Portable fundus camera image. 60° FOV
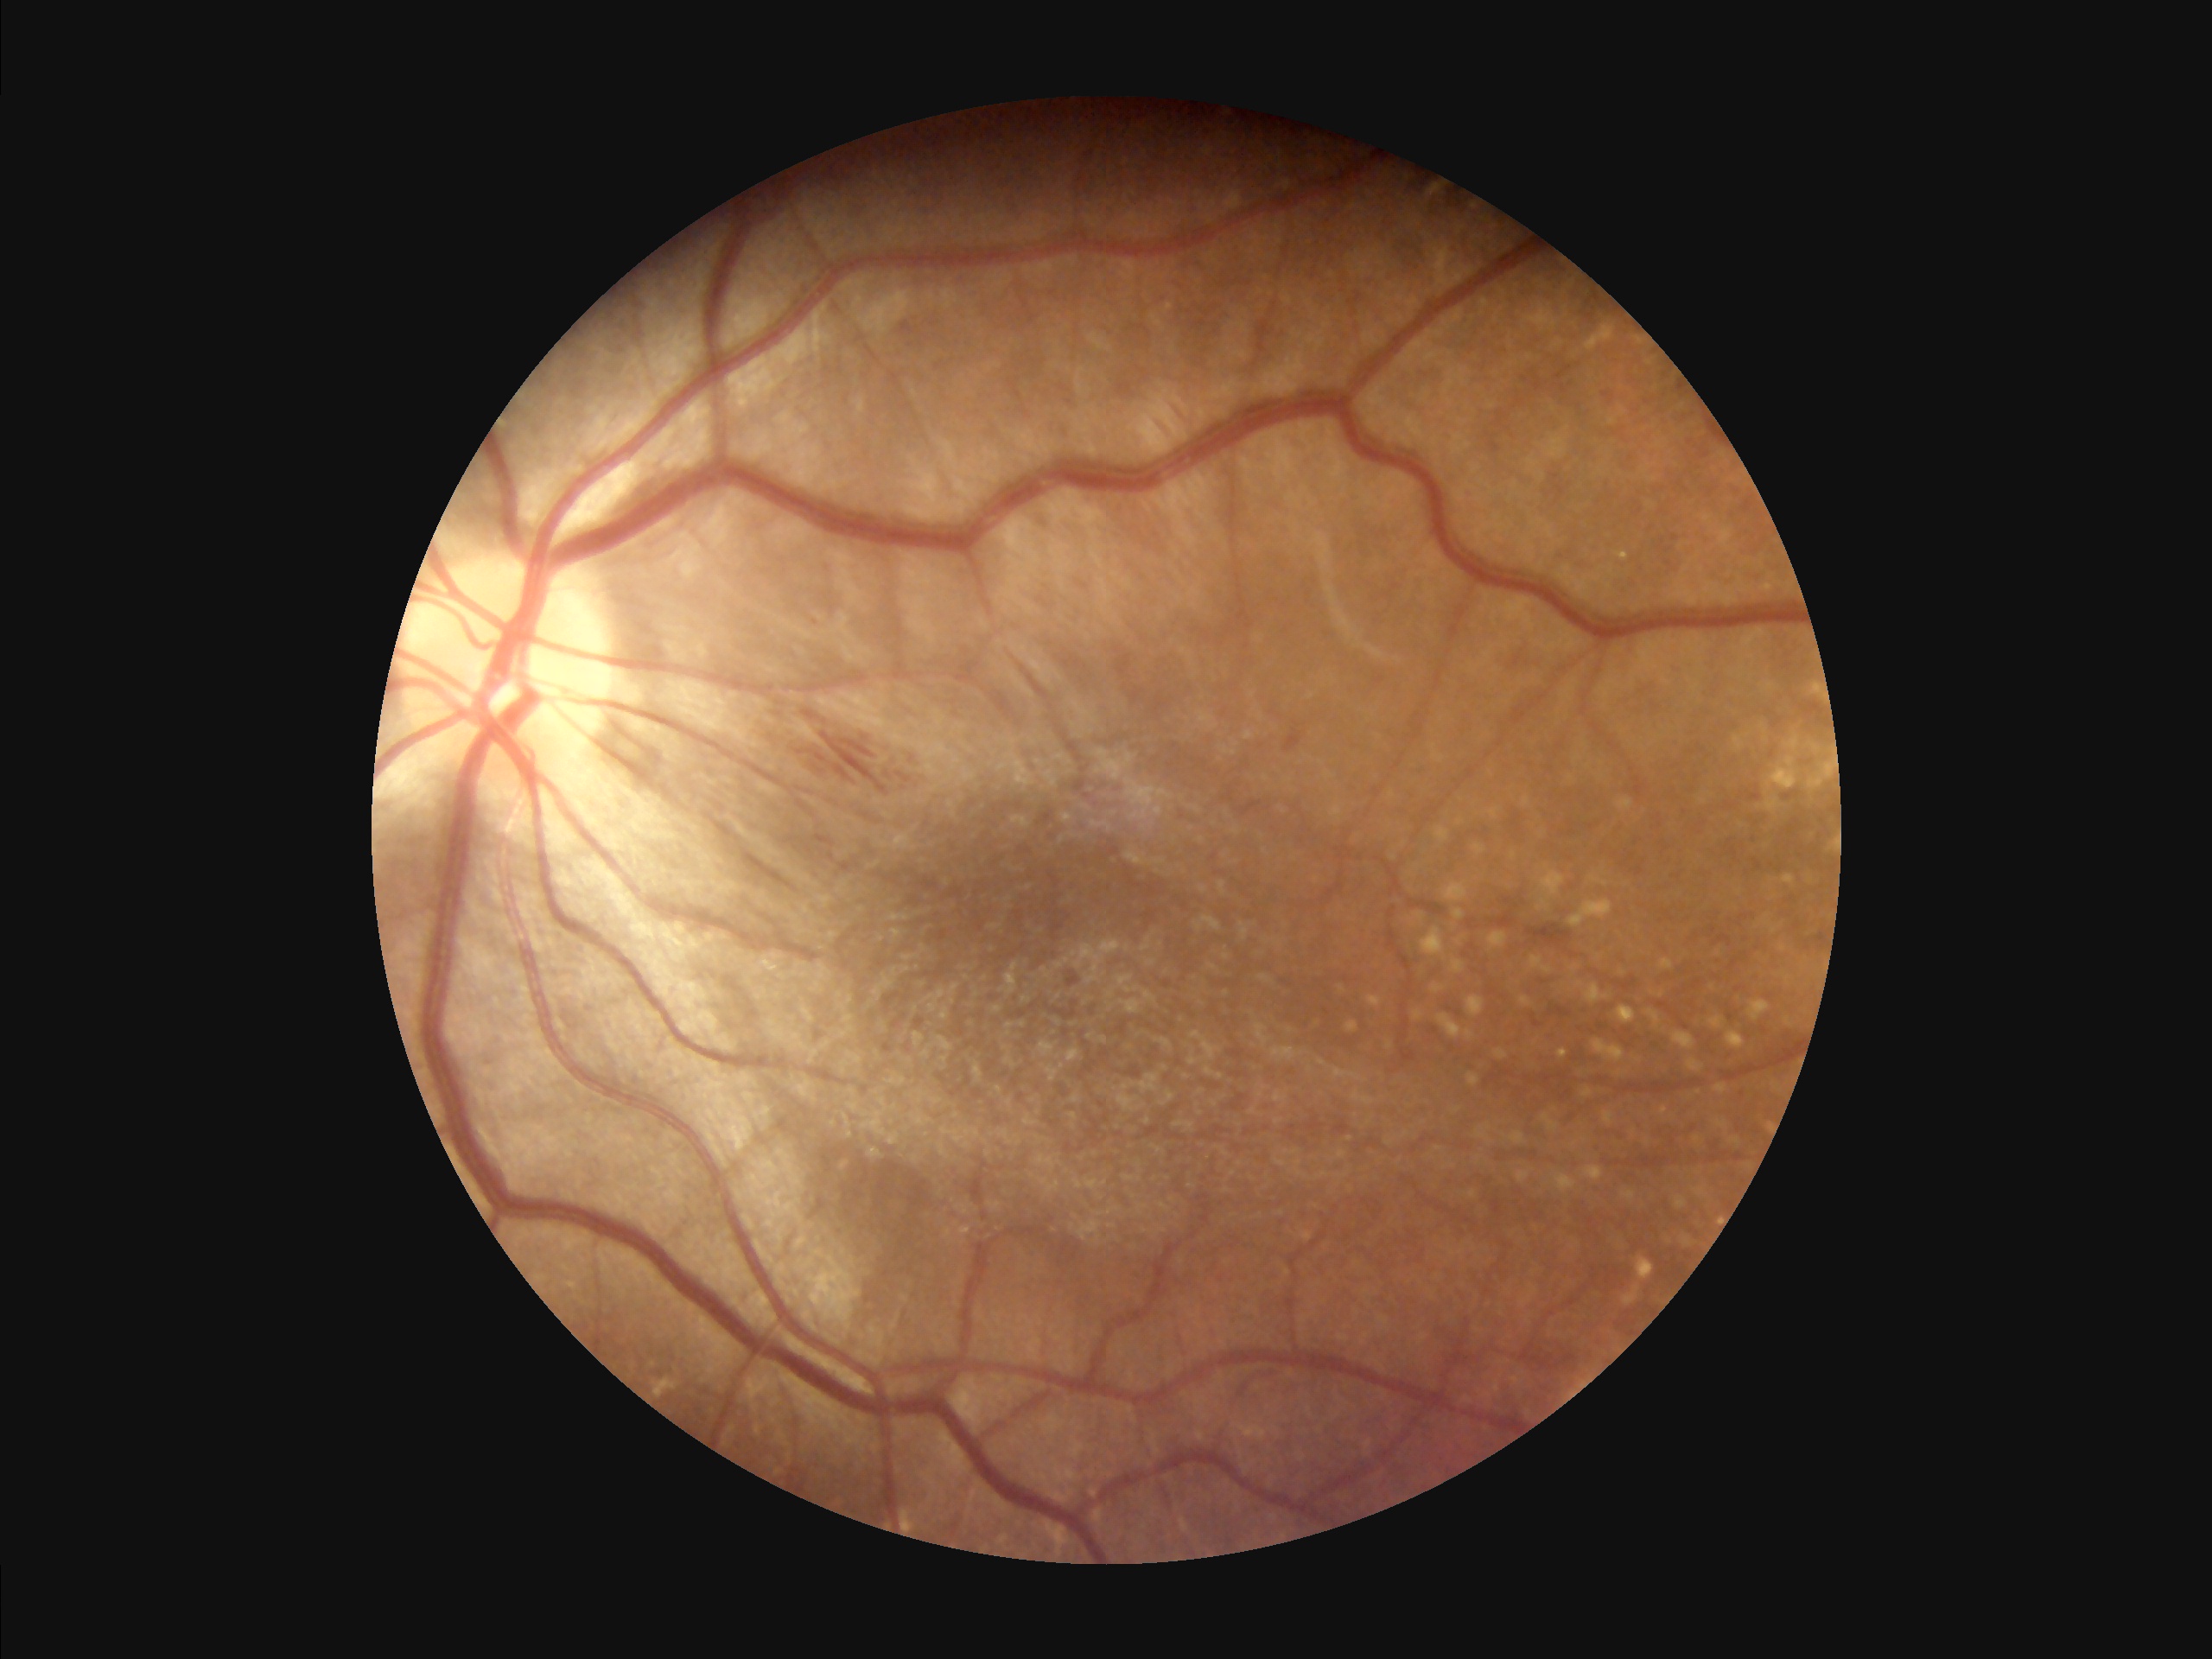
Contrast: adequate; Overall image quality: acceptable; Sharpness: sharp.